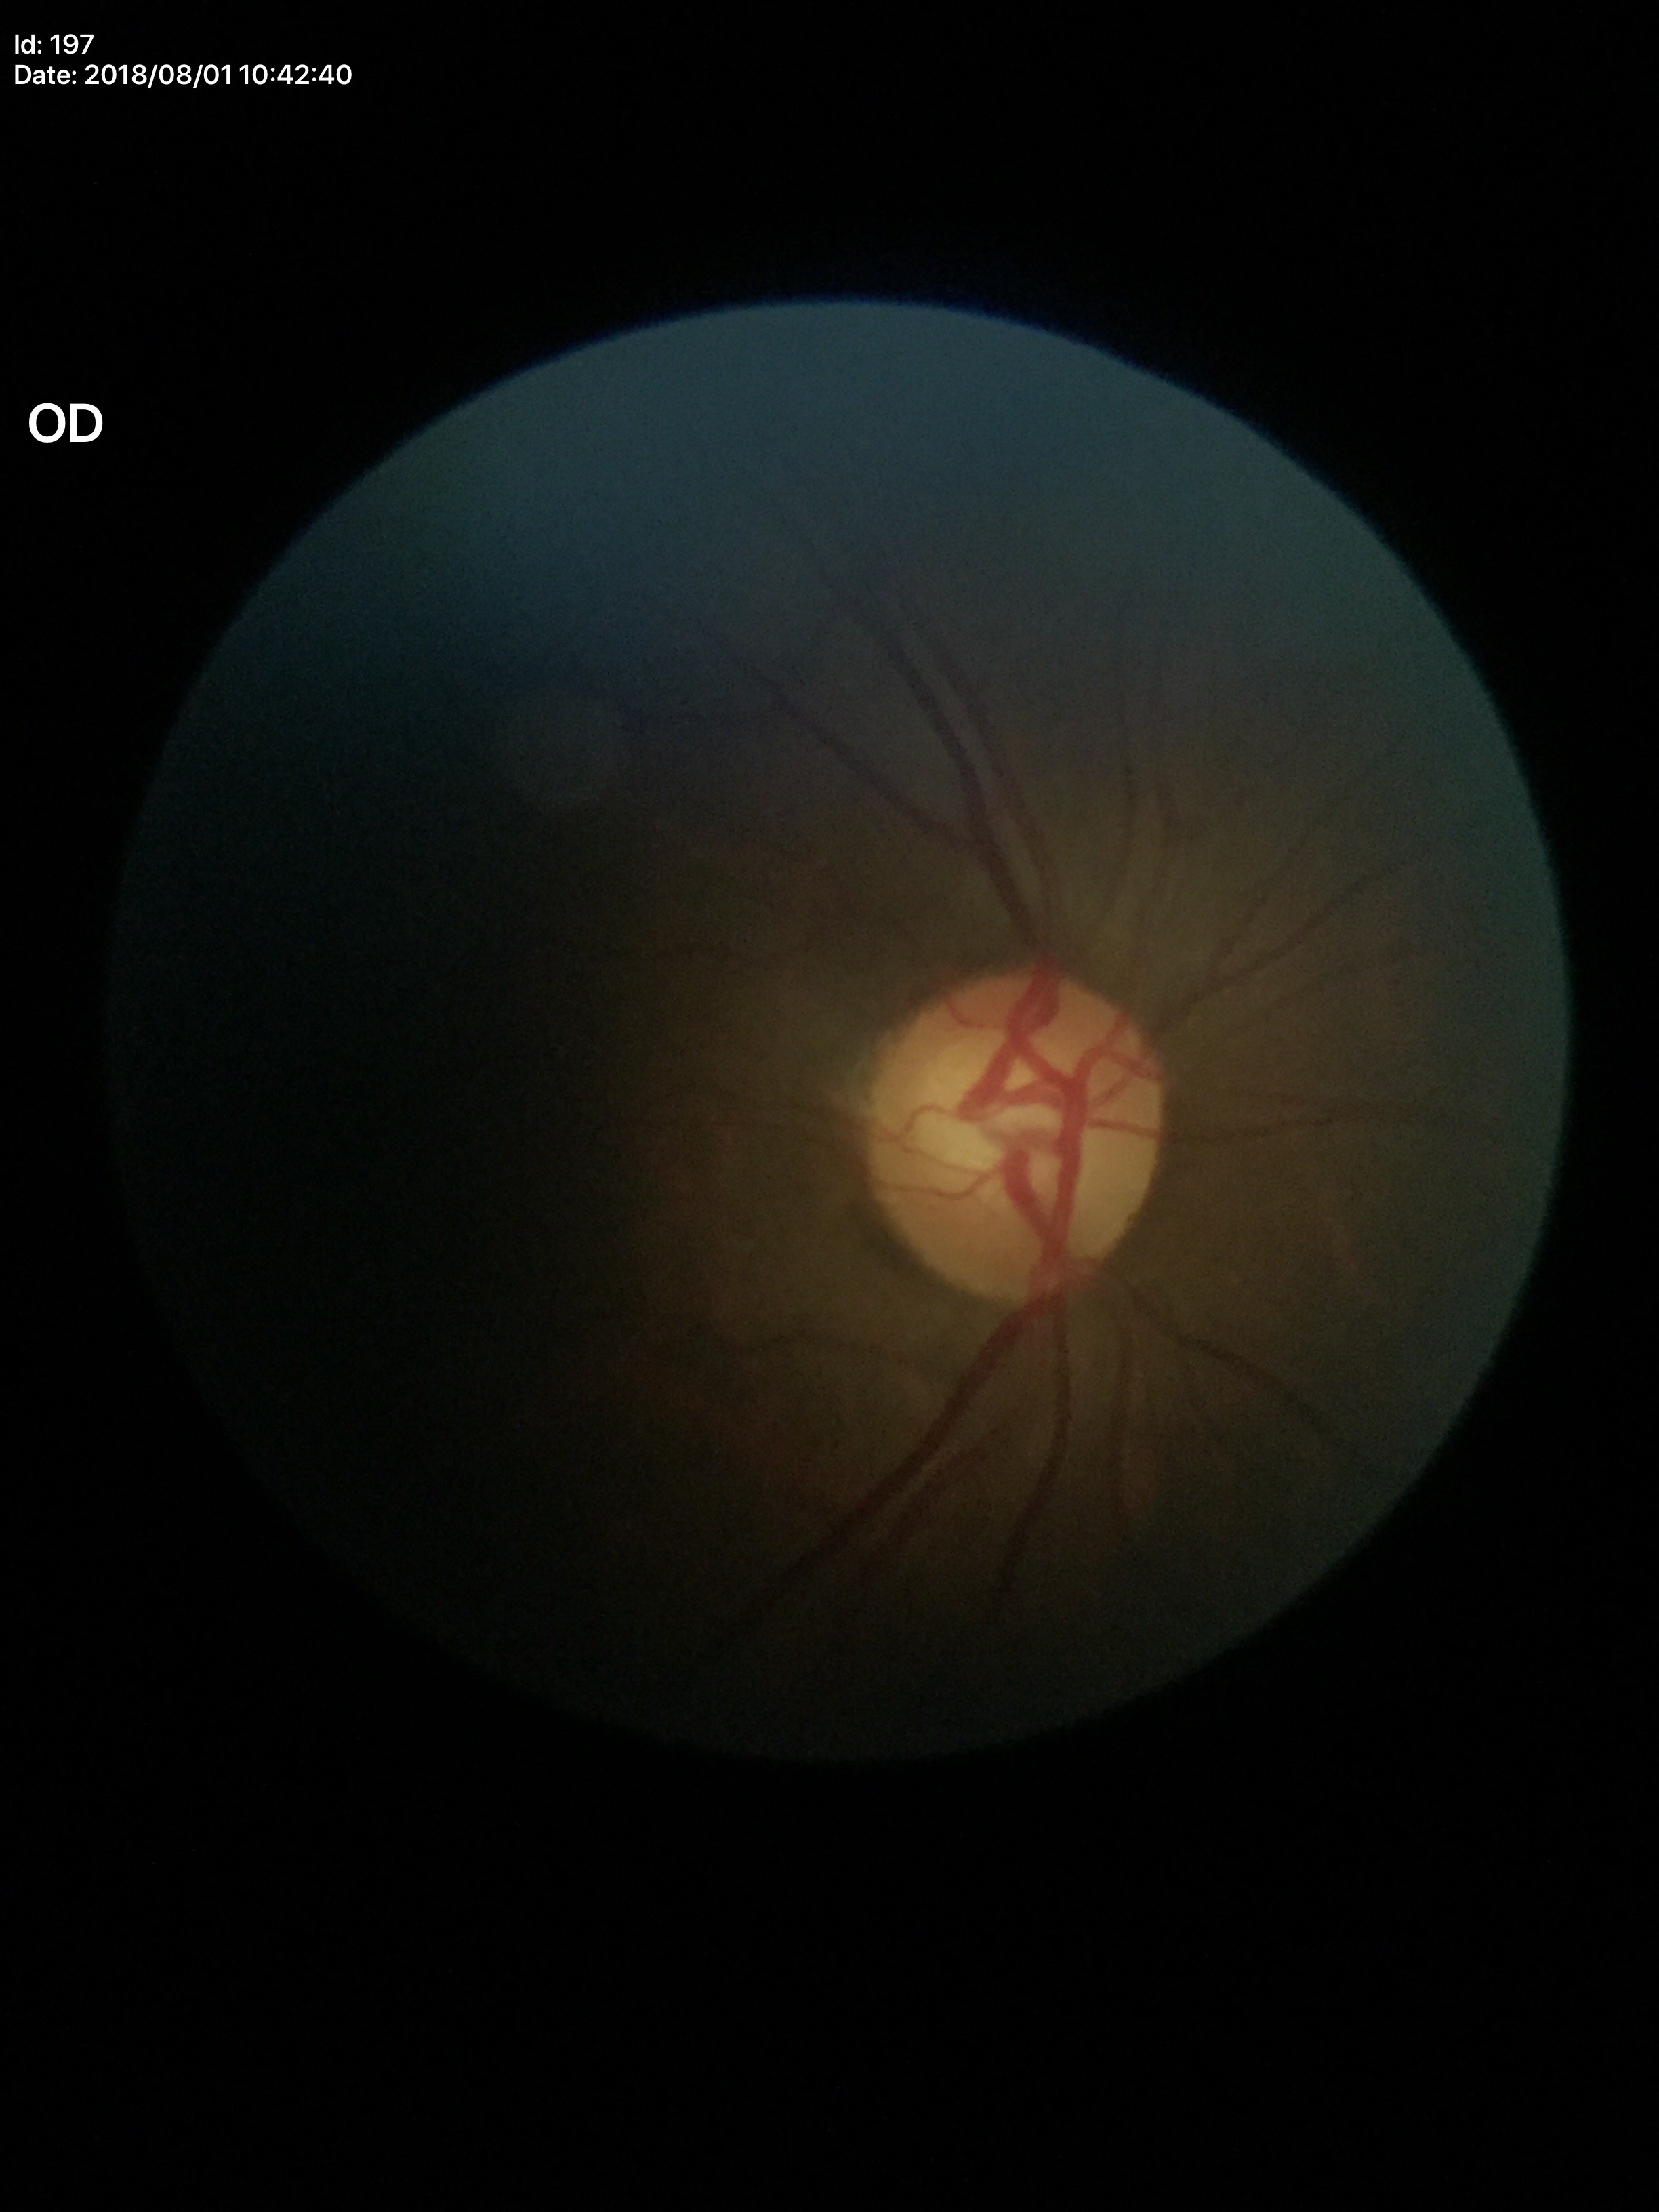

Glaucoma assessment: not suspect. Horizontal C/D ratio: 0.64. Vertical cup-to-disc ratio of 0.59.